Diabetic retinopathy graded by the modified Davis classification:
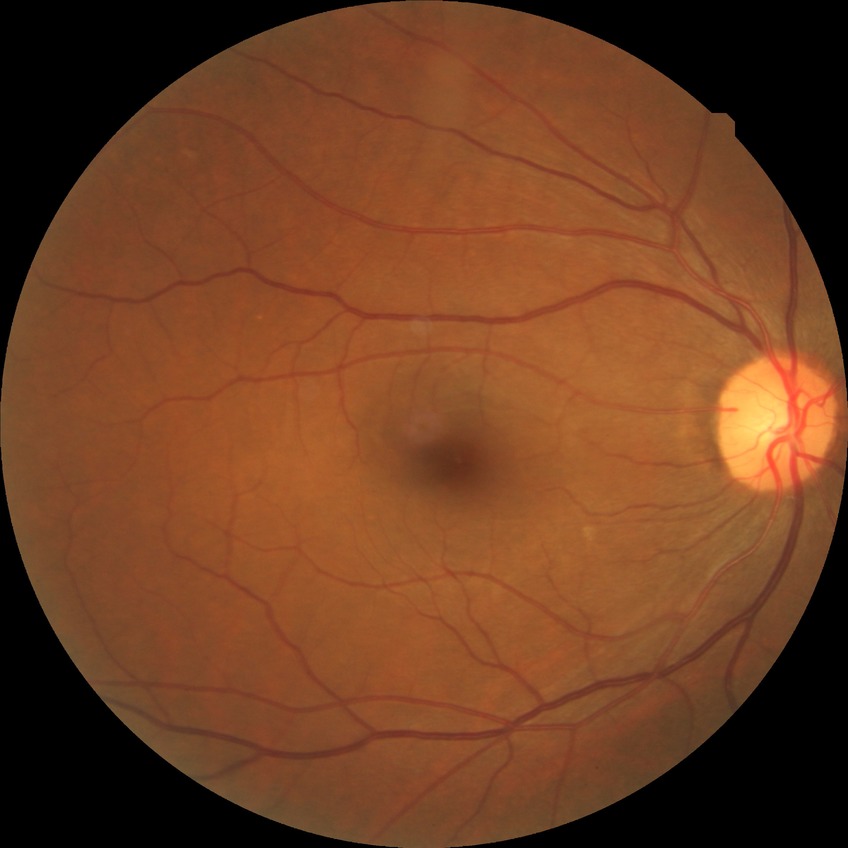

diabetic retinopathy (DR): NDR (no diabetic retinopathy)